640 x 480 pixels · wide-field contact fundus photograph of an infant
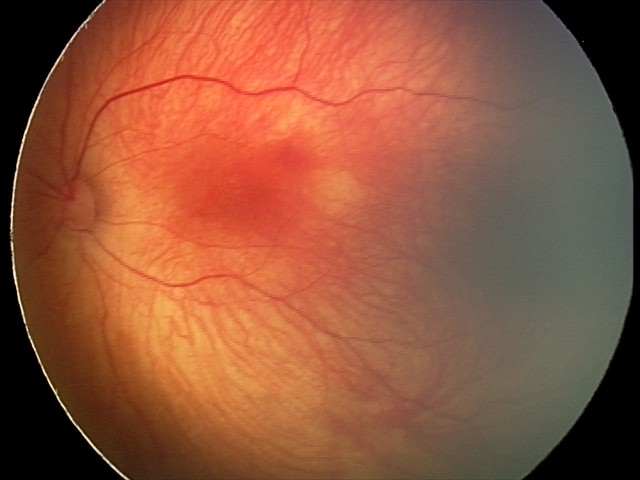 Series diagnosed as retinal hemorrhages.